Acquired with a Remidio FOP fundus camera:
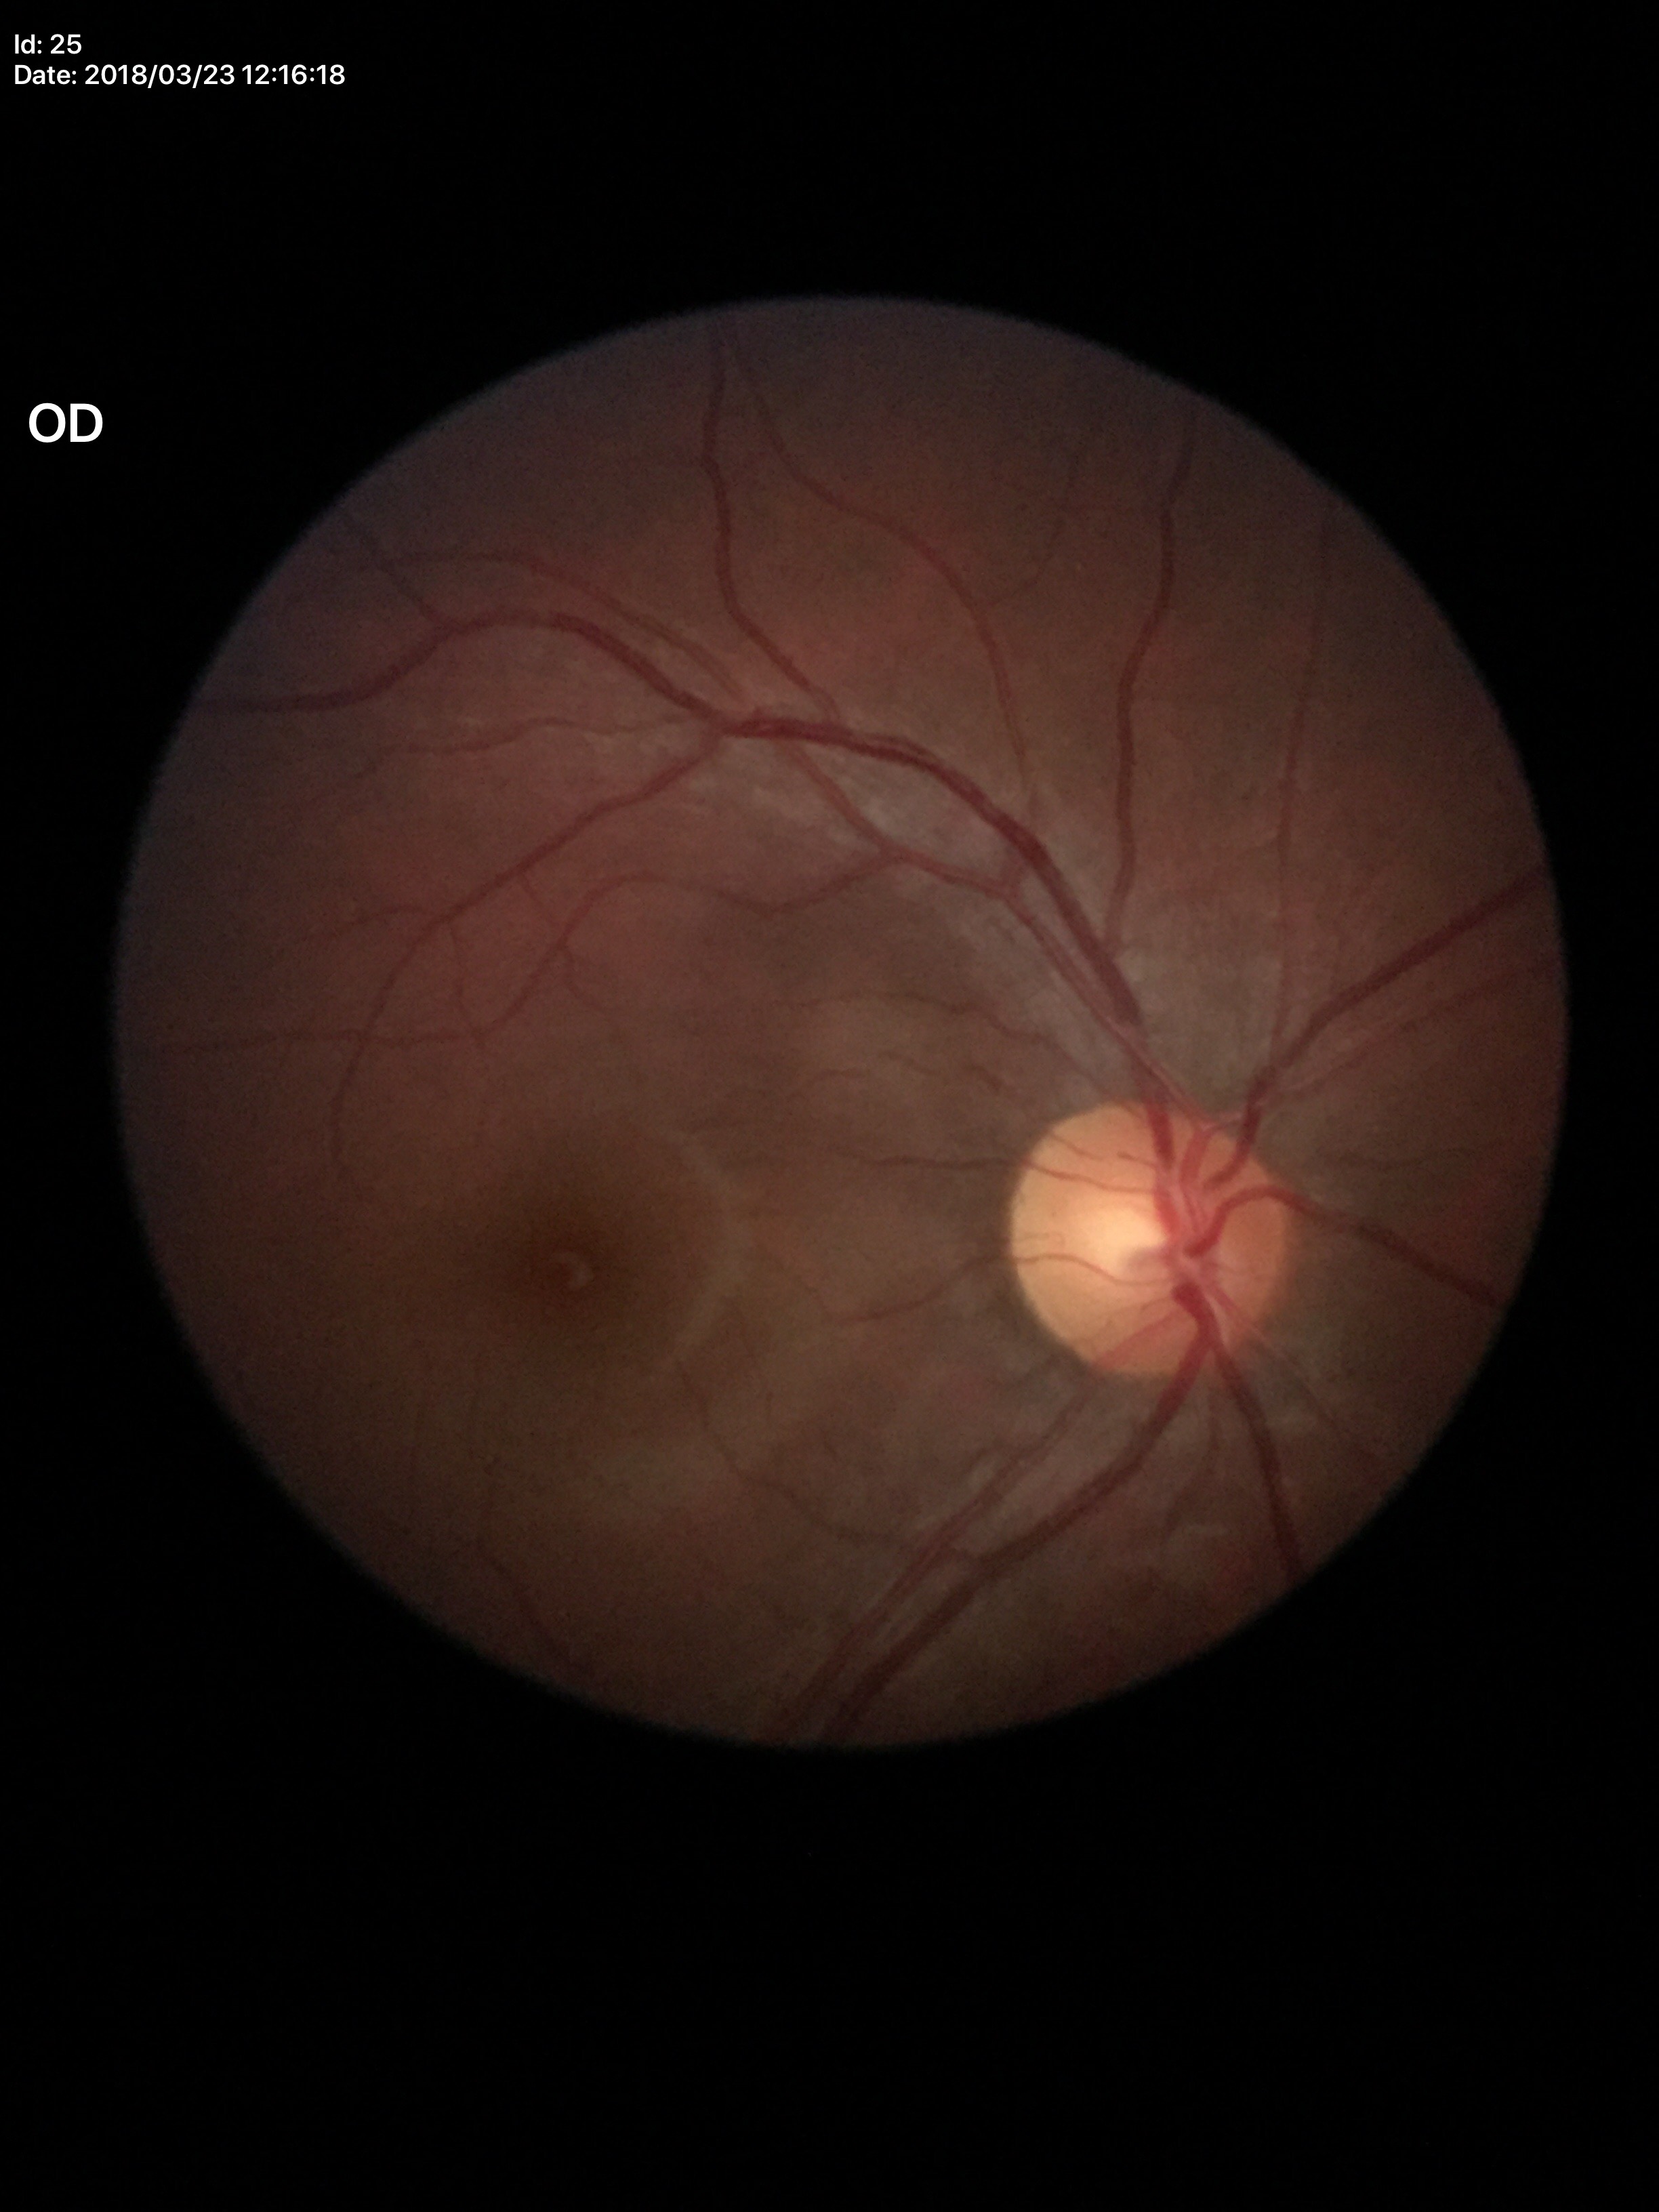 Glaucoma evaluation: not suspect.
Vertical CDR (VCDR) is 0.48.
Horizontal cup-disc ratio (HCDR): 0.53.